2352 x 1568 pixels:
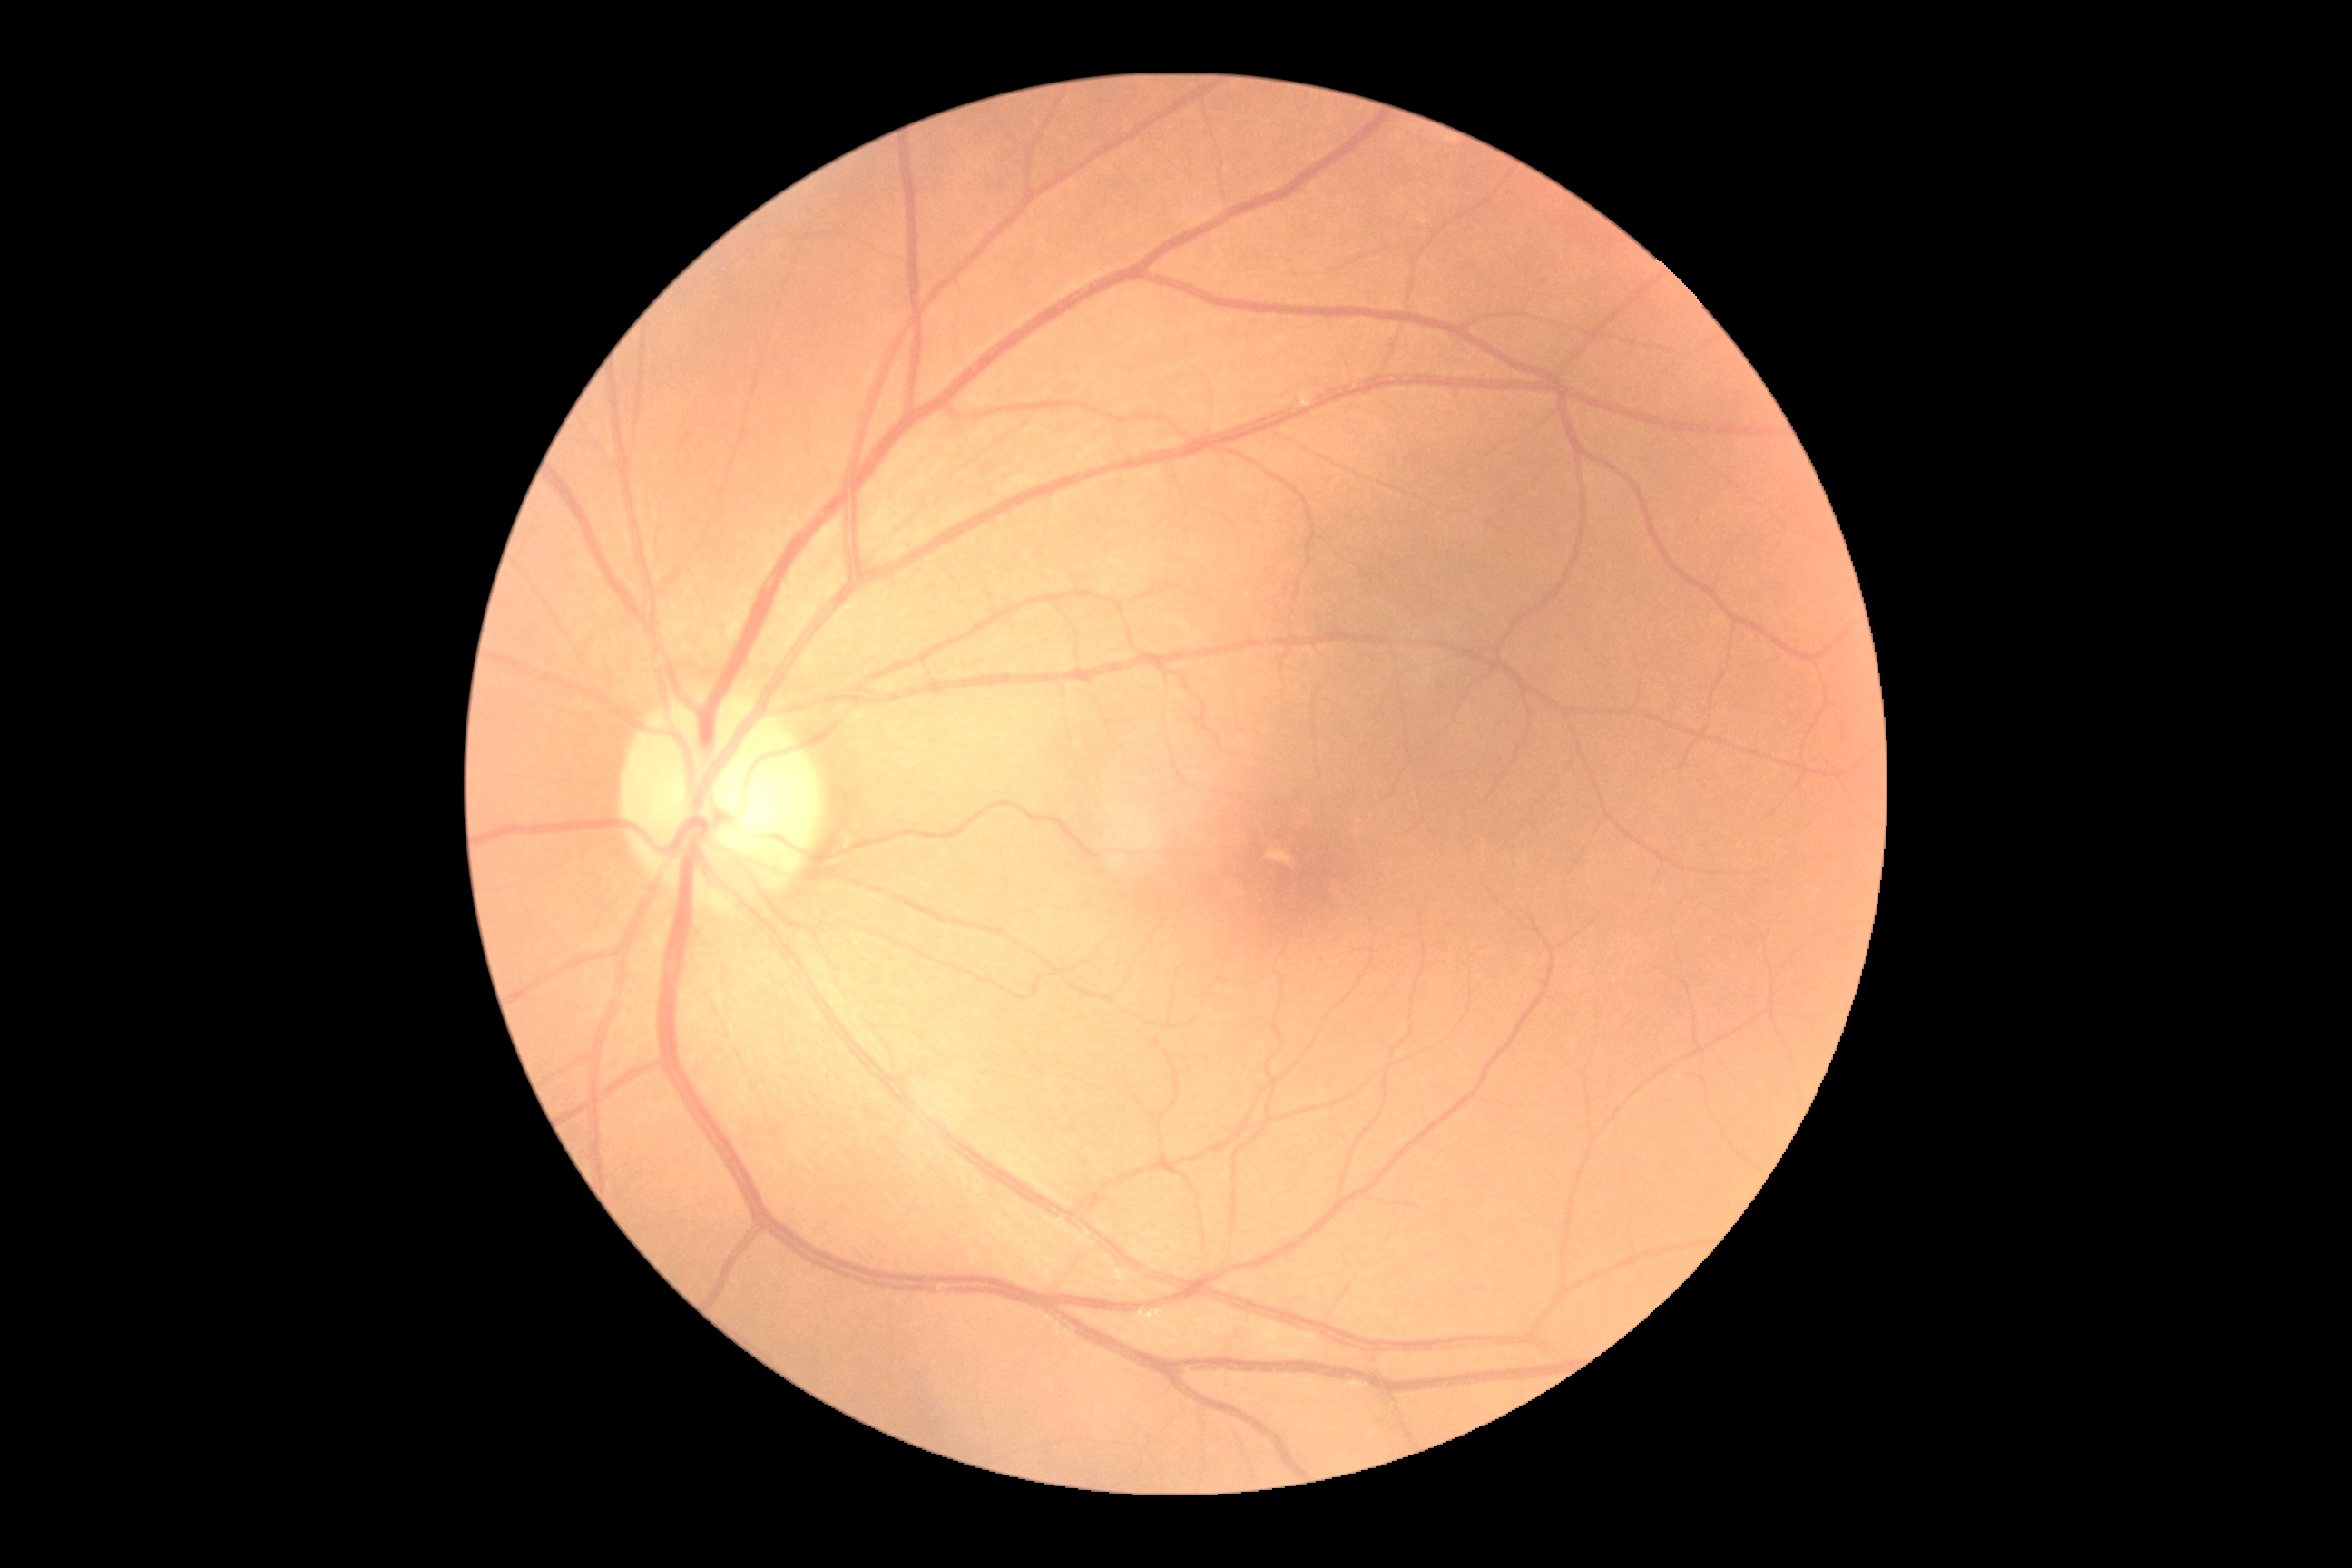 DR grade is no apparent diabetic retinopathy (0).